Graded on the modified Davis scale. 45 degree fundus photograph. No pharmacologic dilation: 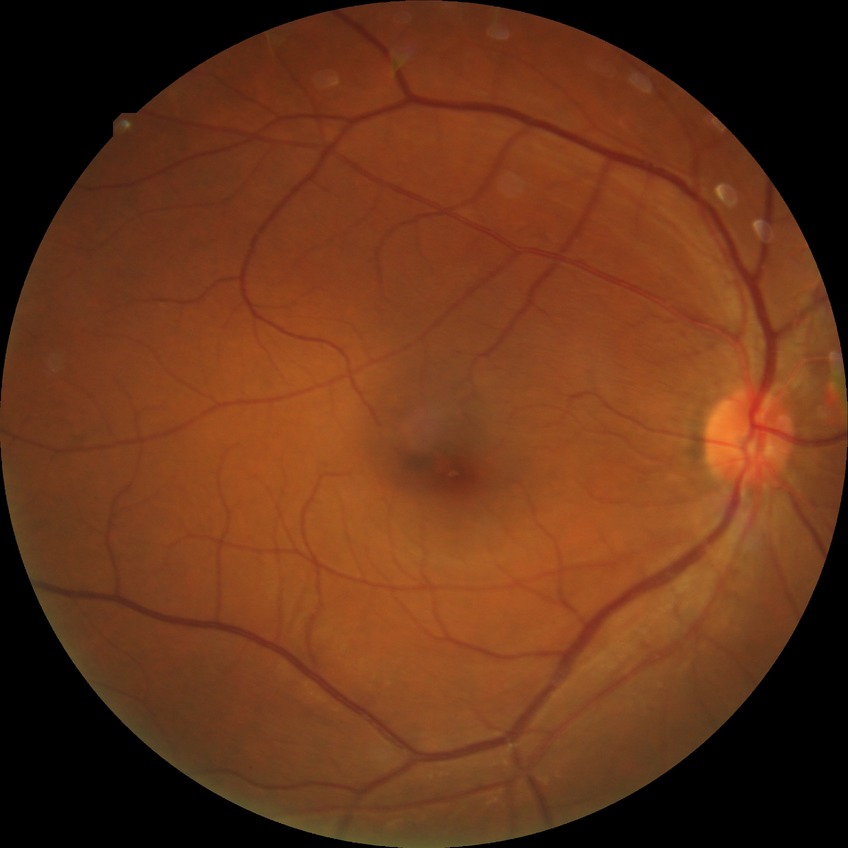
Diabetic retinopathy grade: no diabetic retinopathy.